FOV: 45 degrees
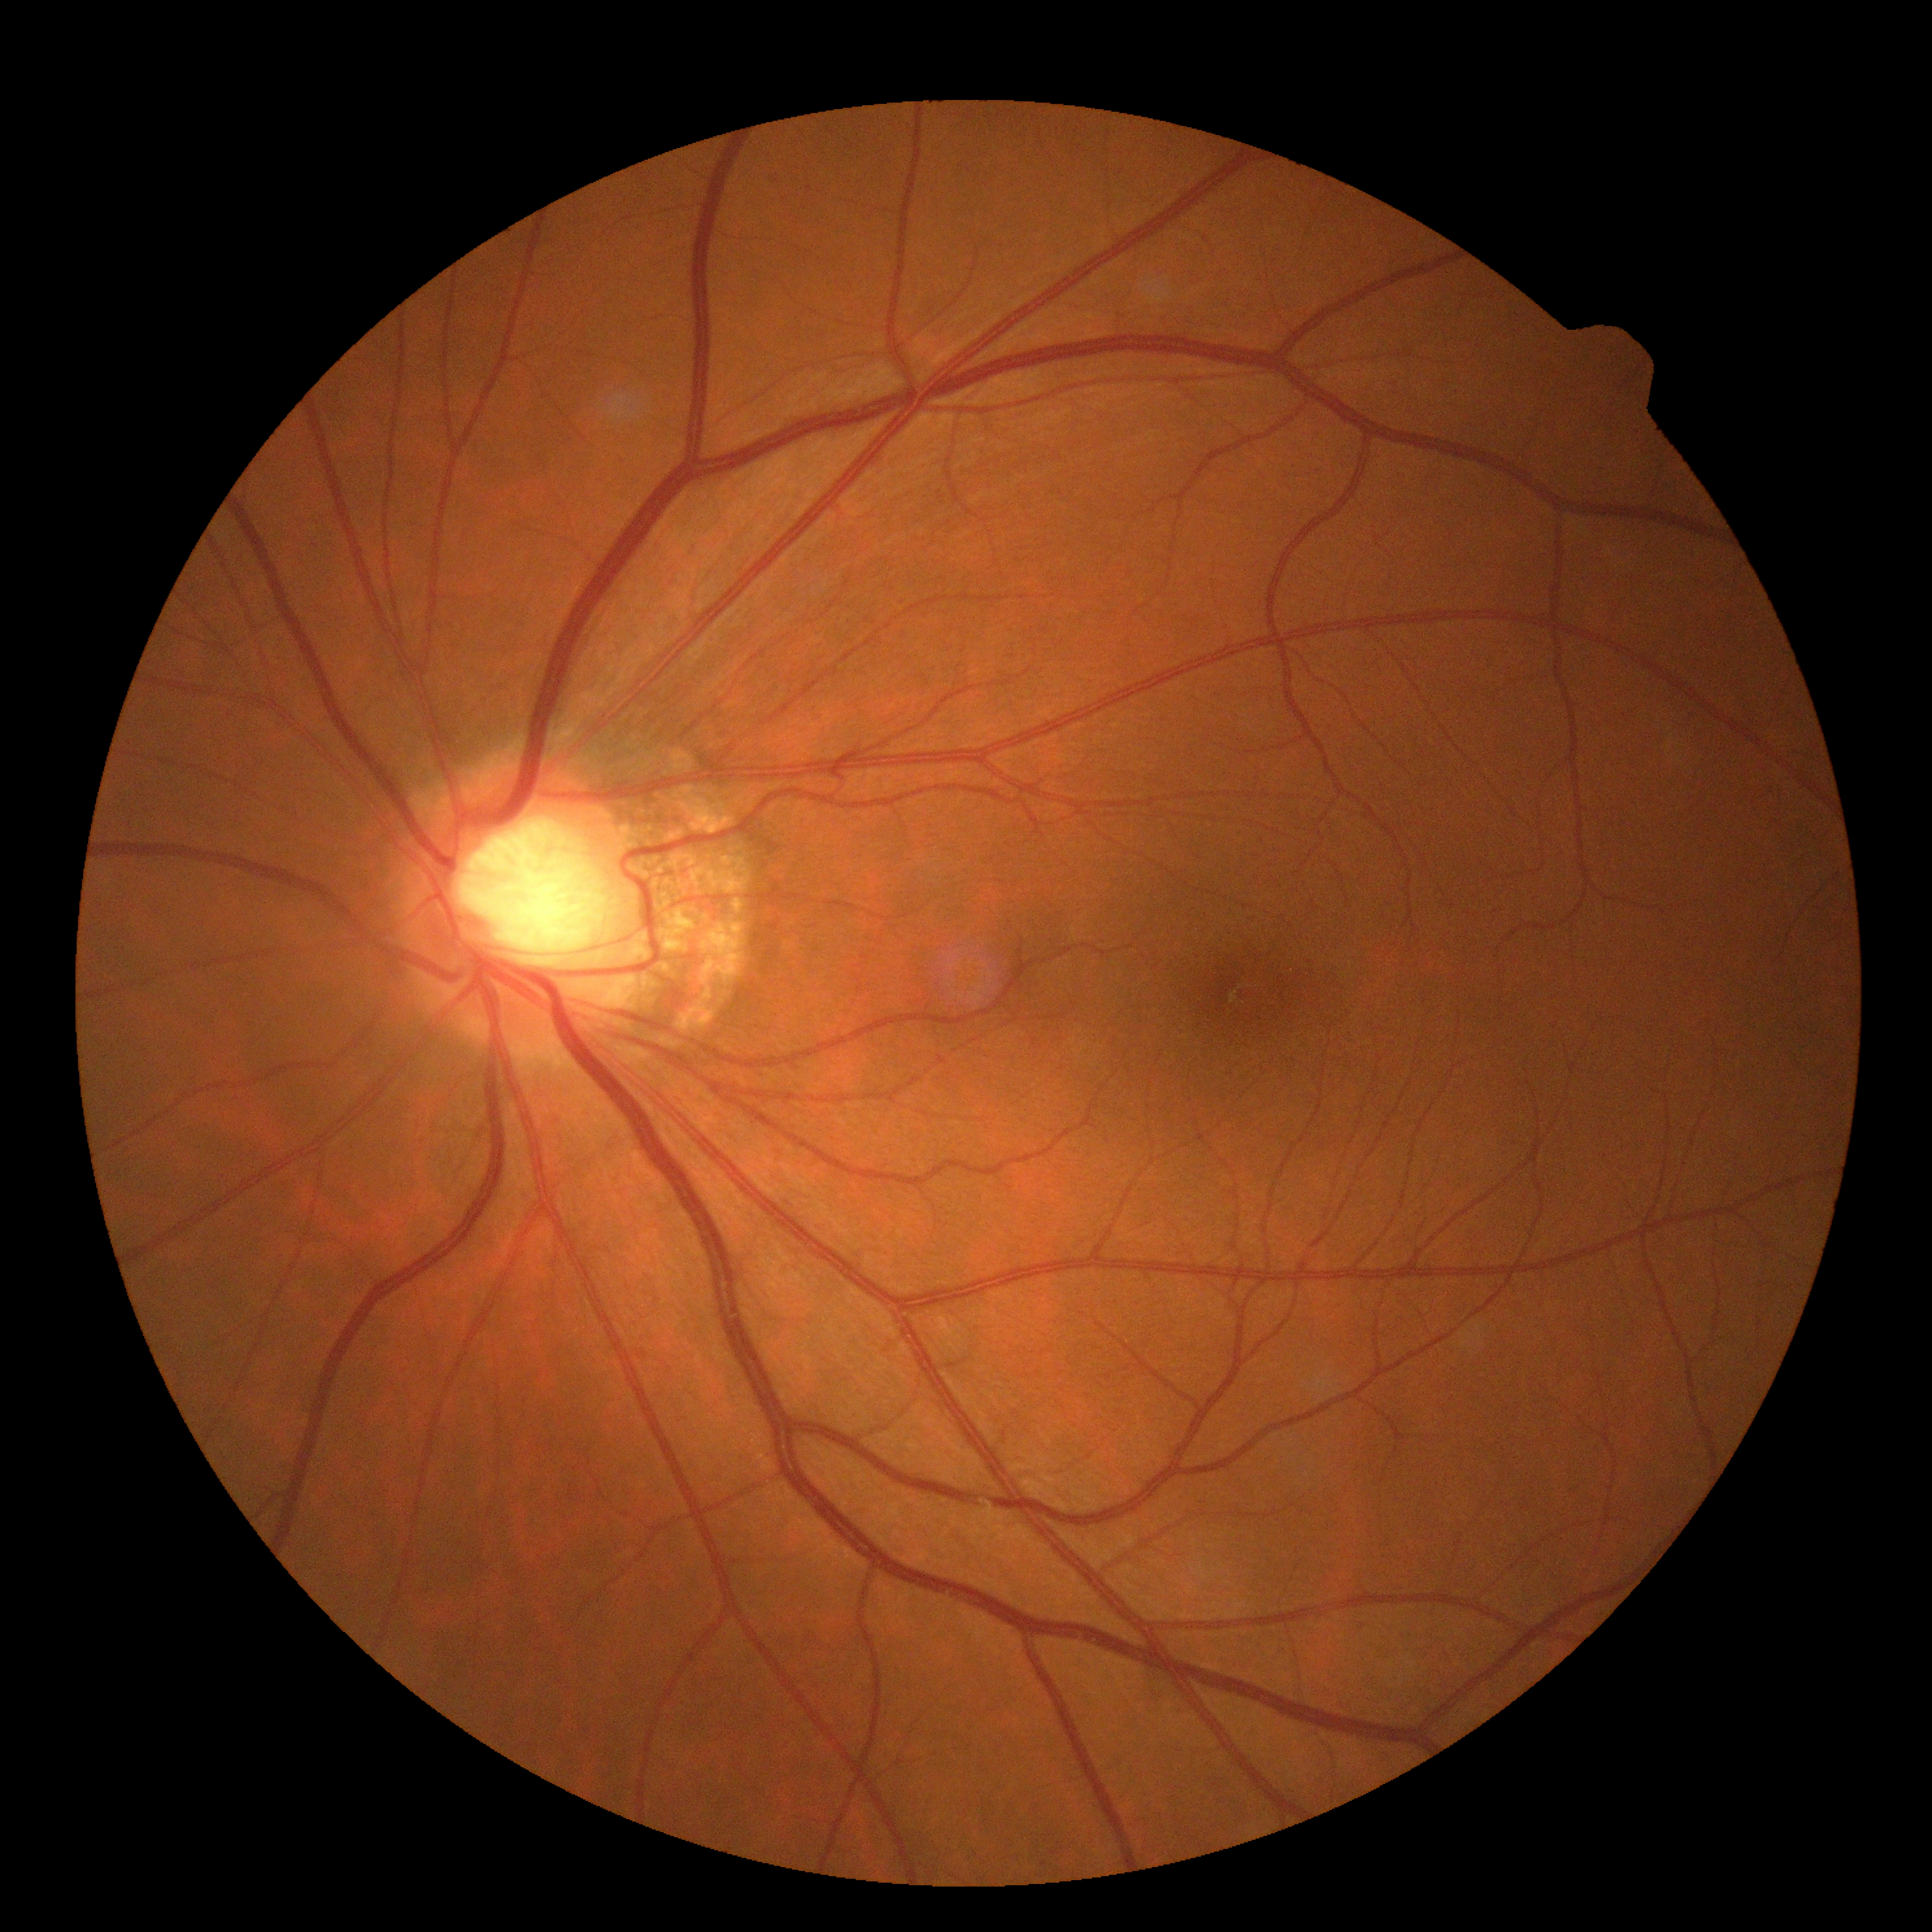

{"dr_grade": "0"}